45° field of view:
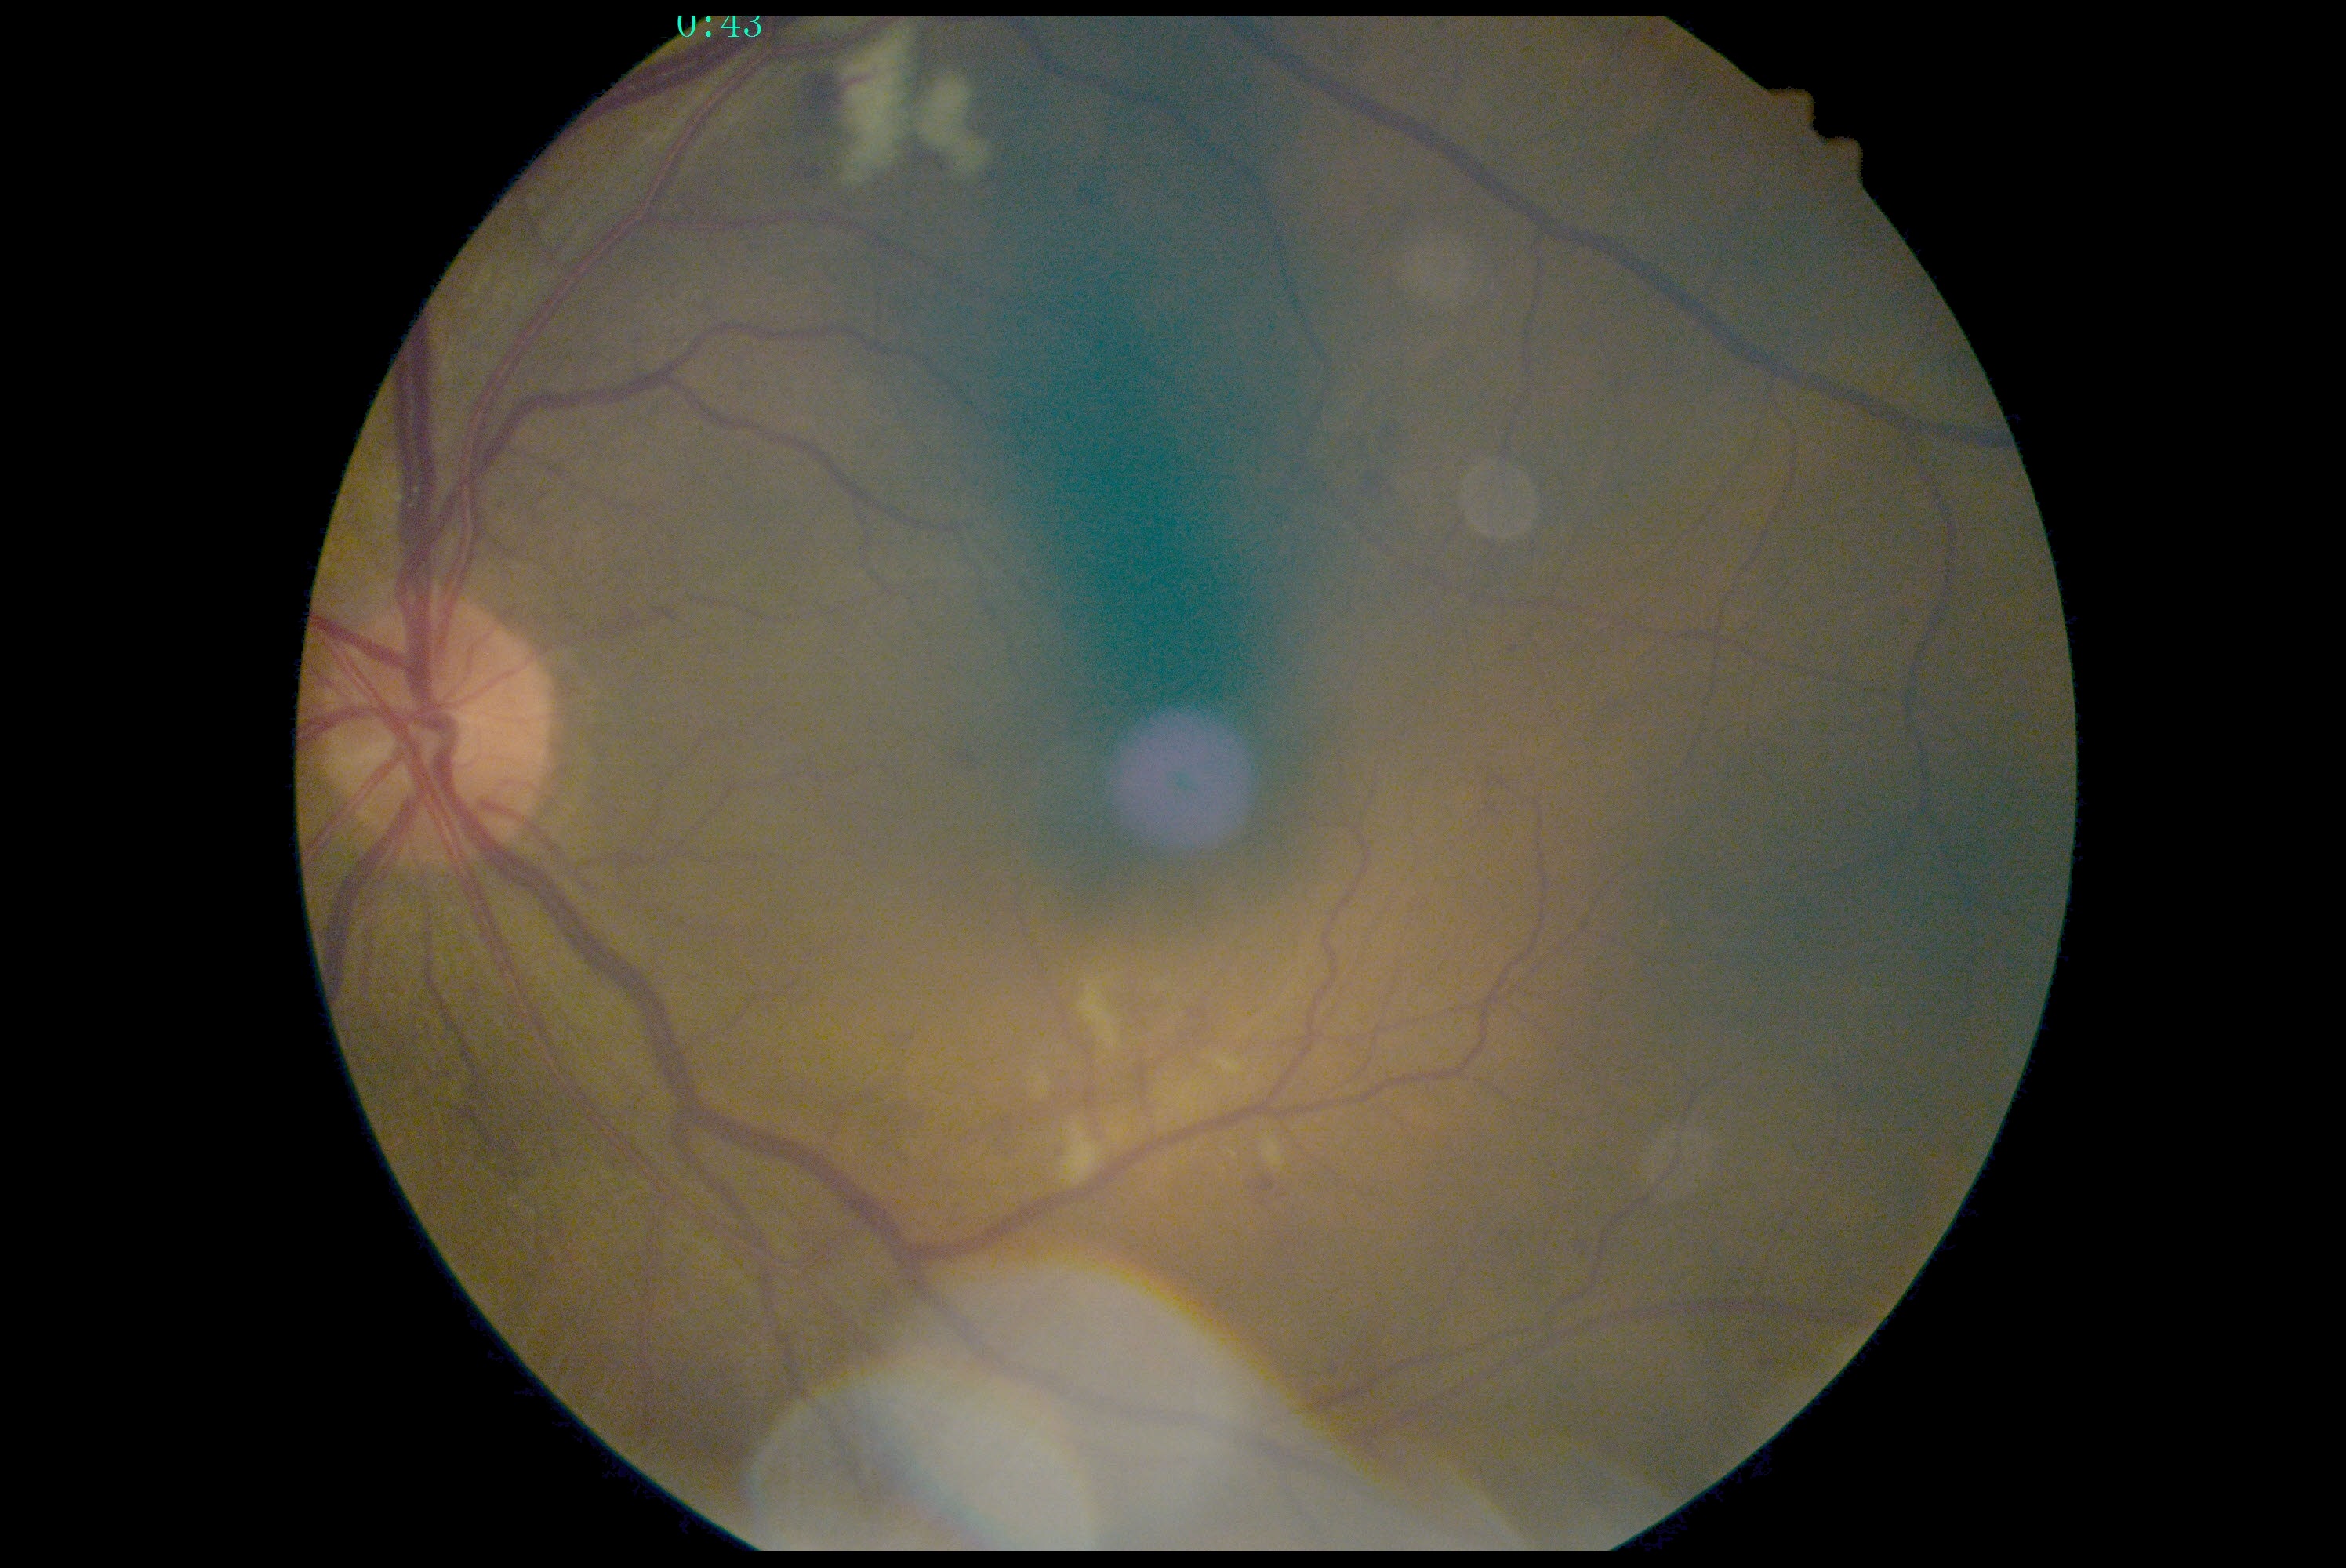
DR is grade 2.